45° FOV · 2352x1568px:
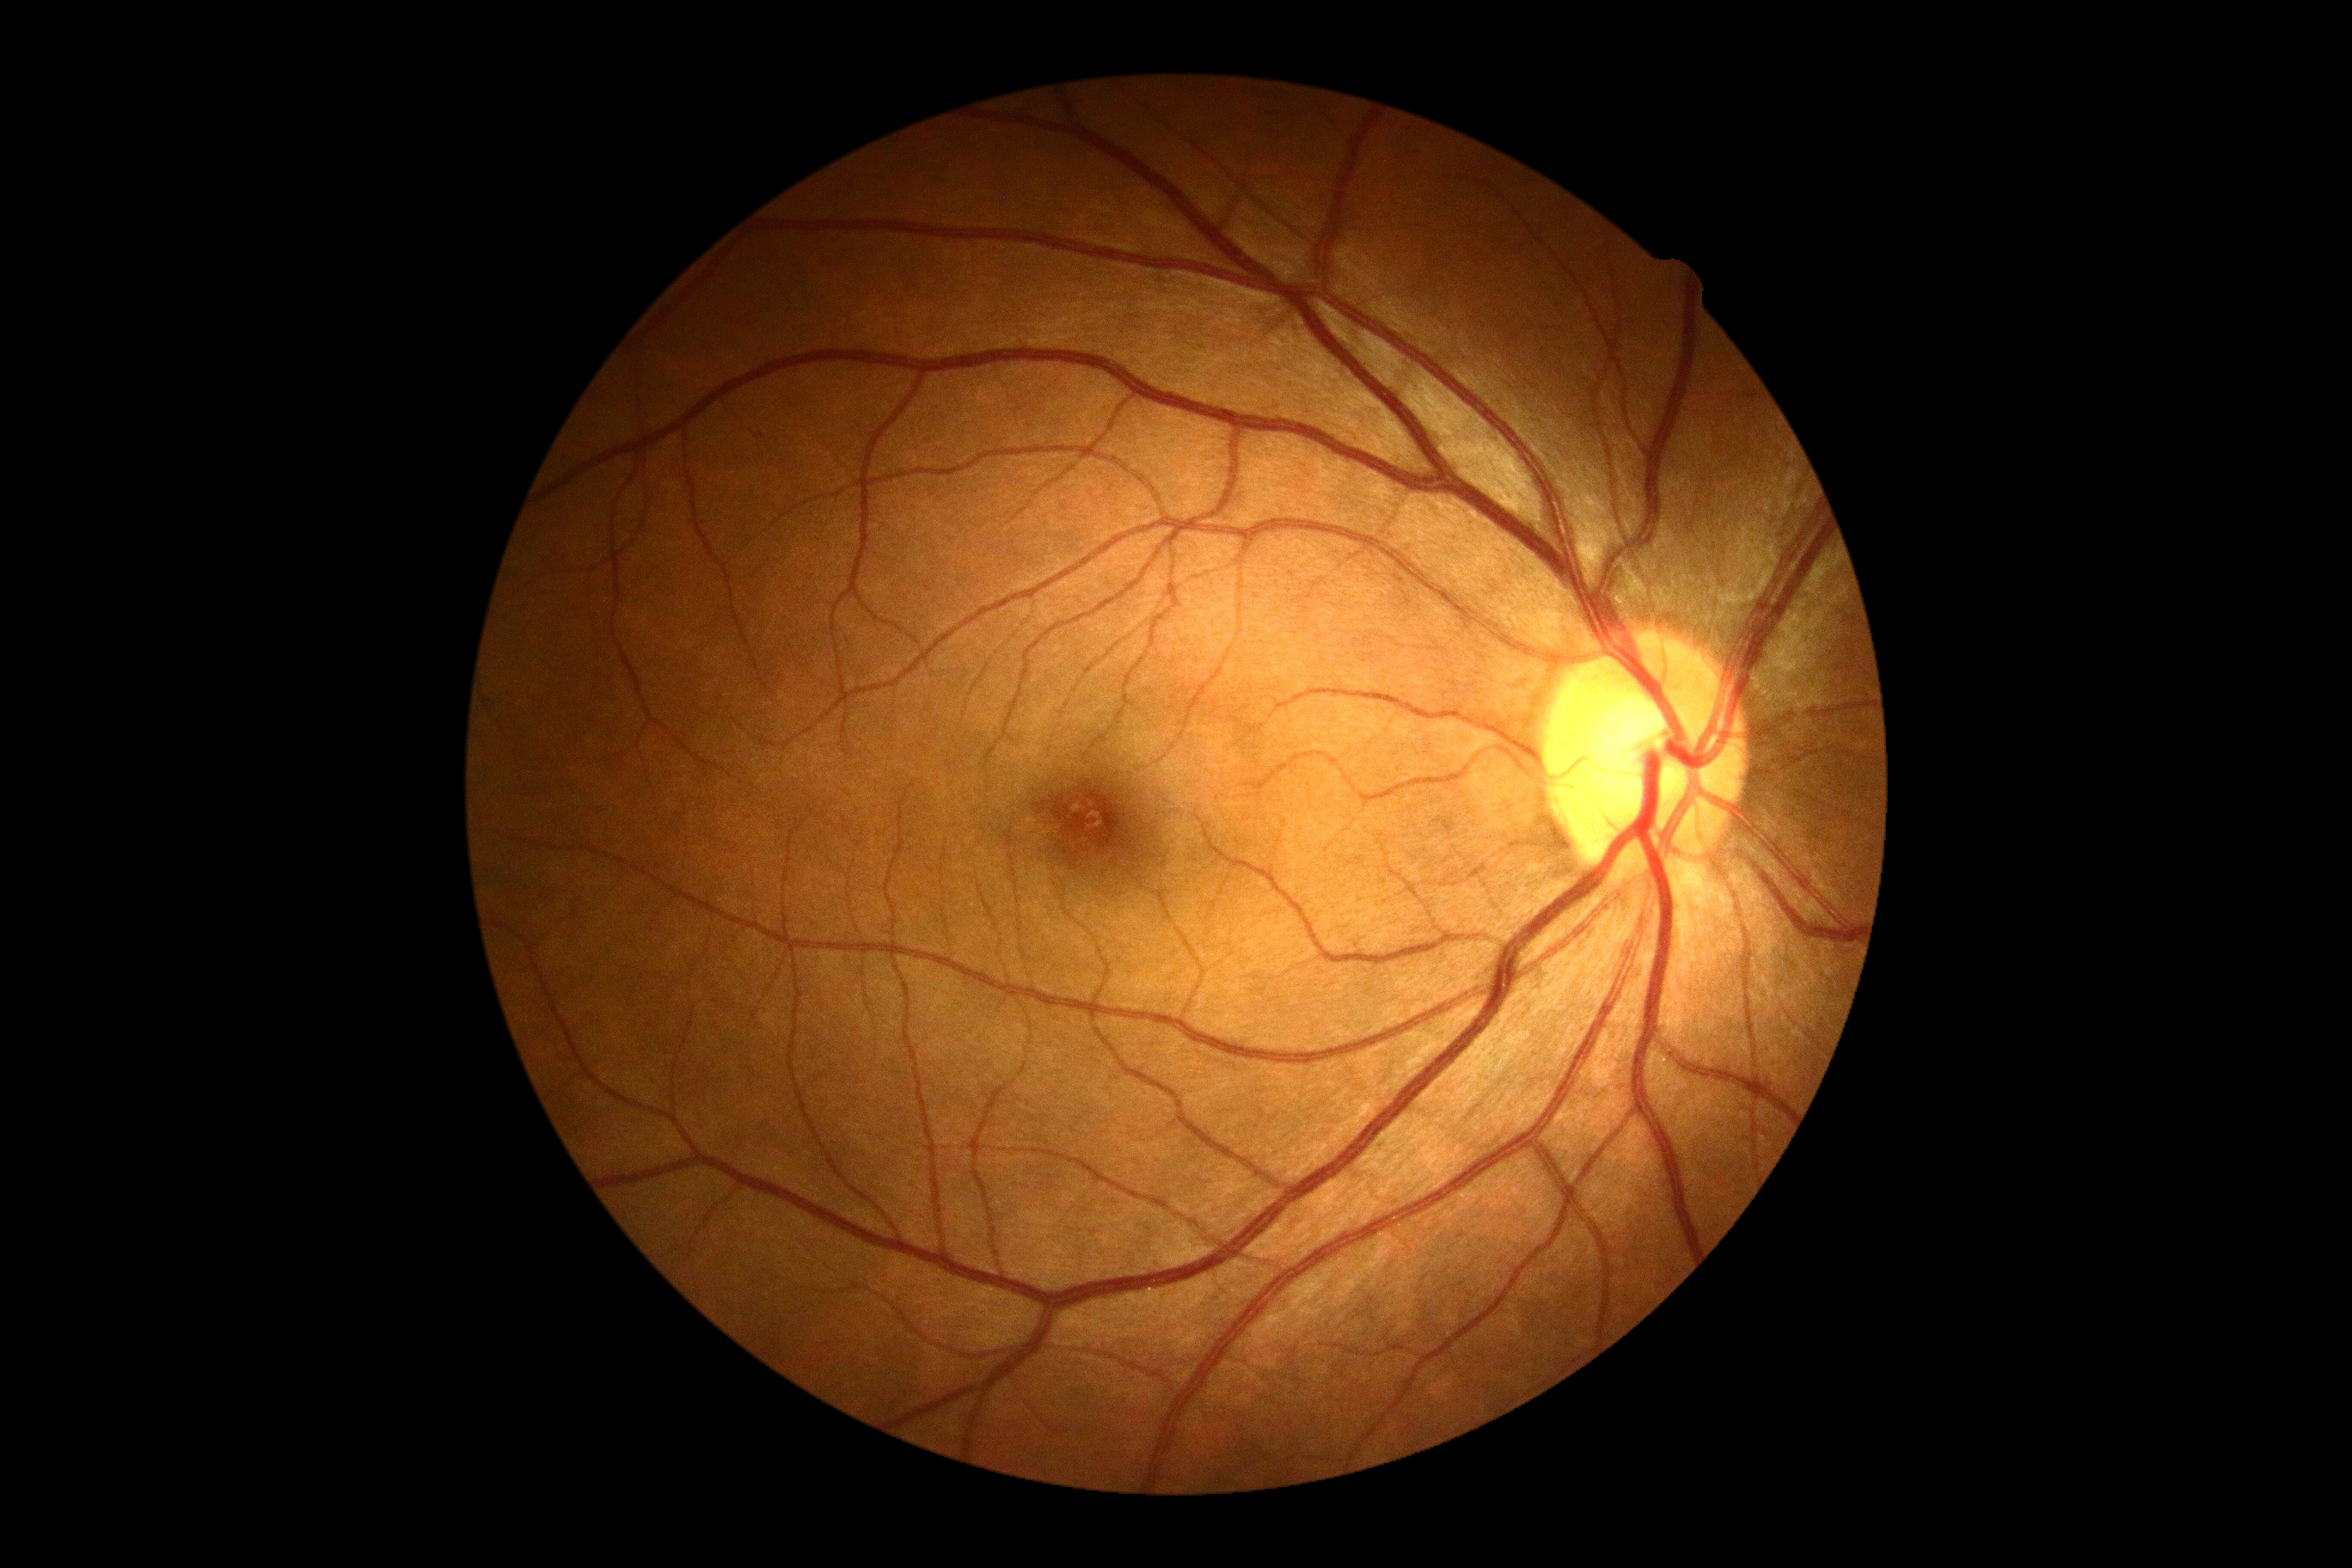

diabetic retinopathy = grade 0 (no apparent retinopathy) — no visible signs of diabetic retinopathy.